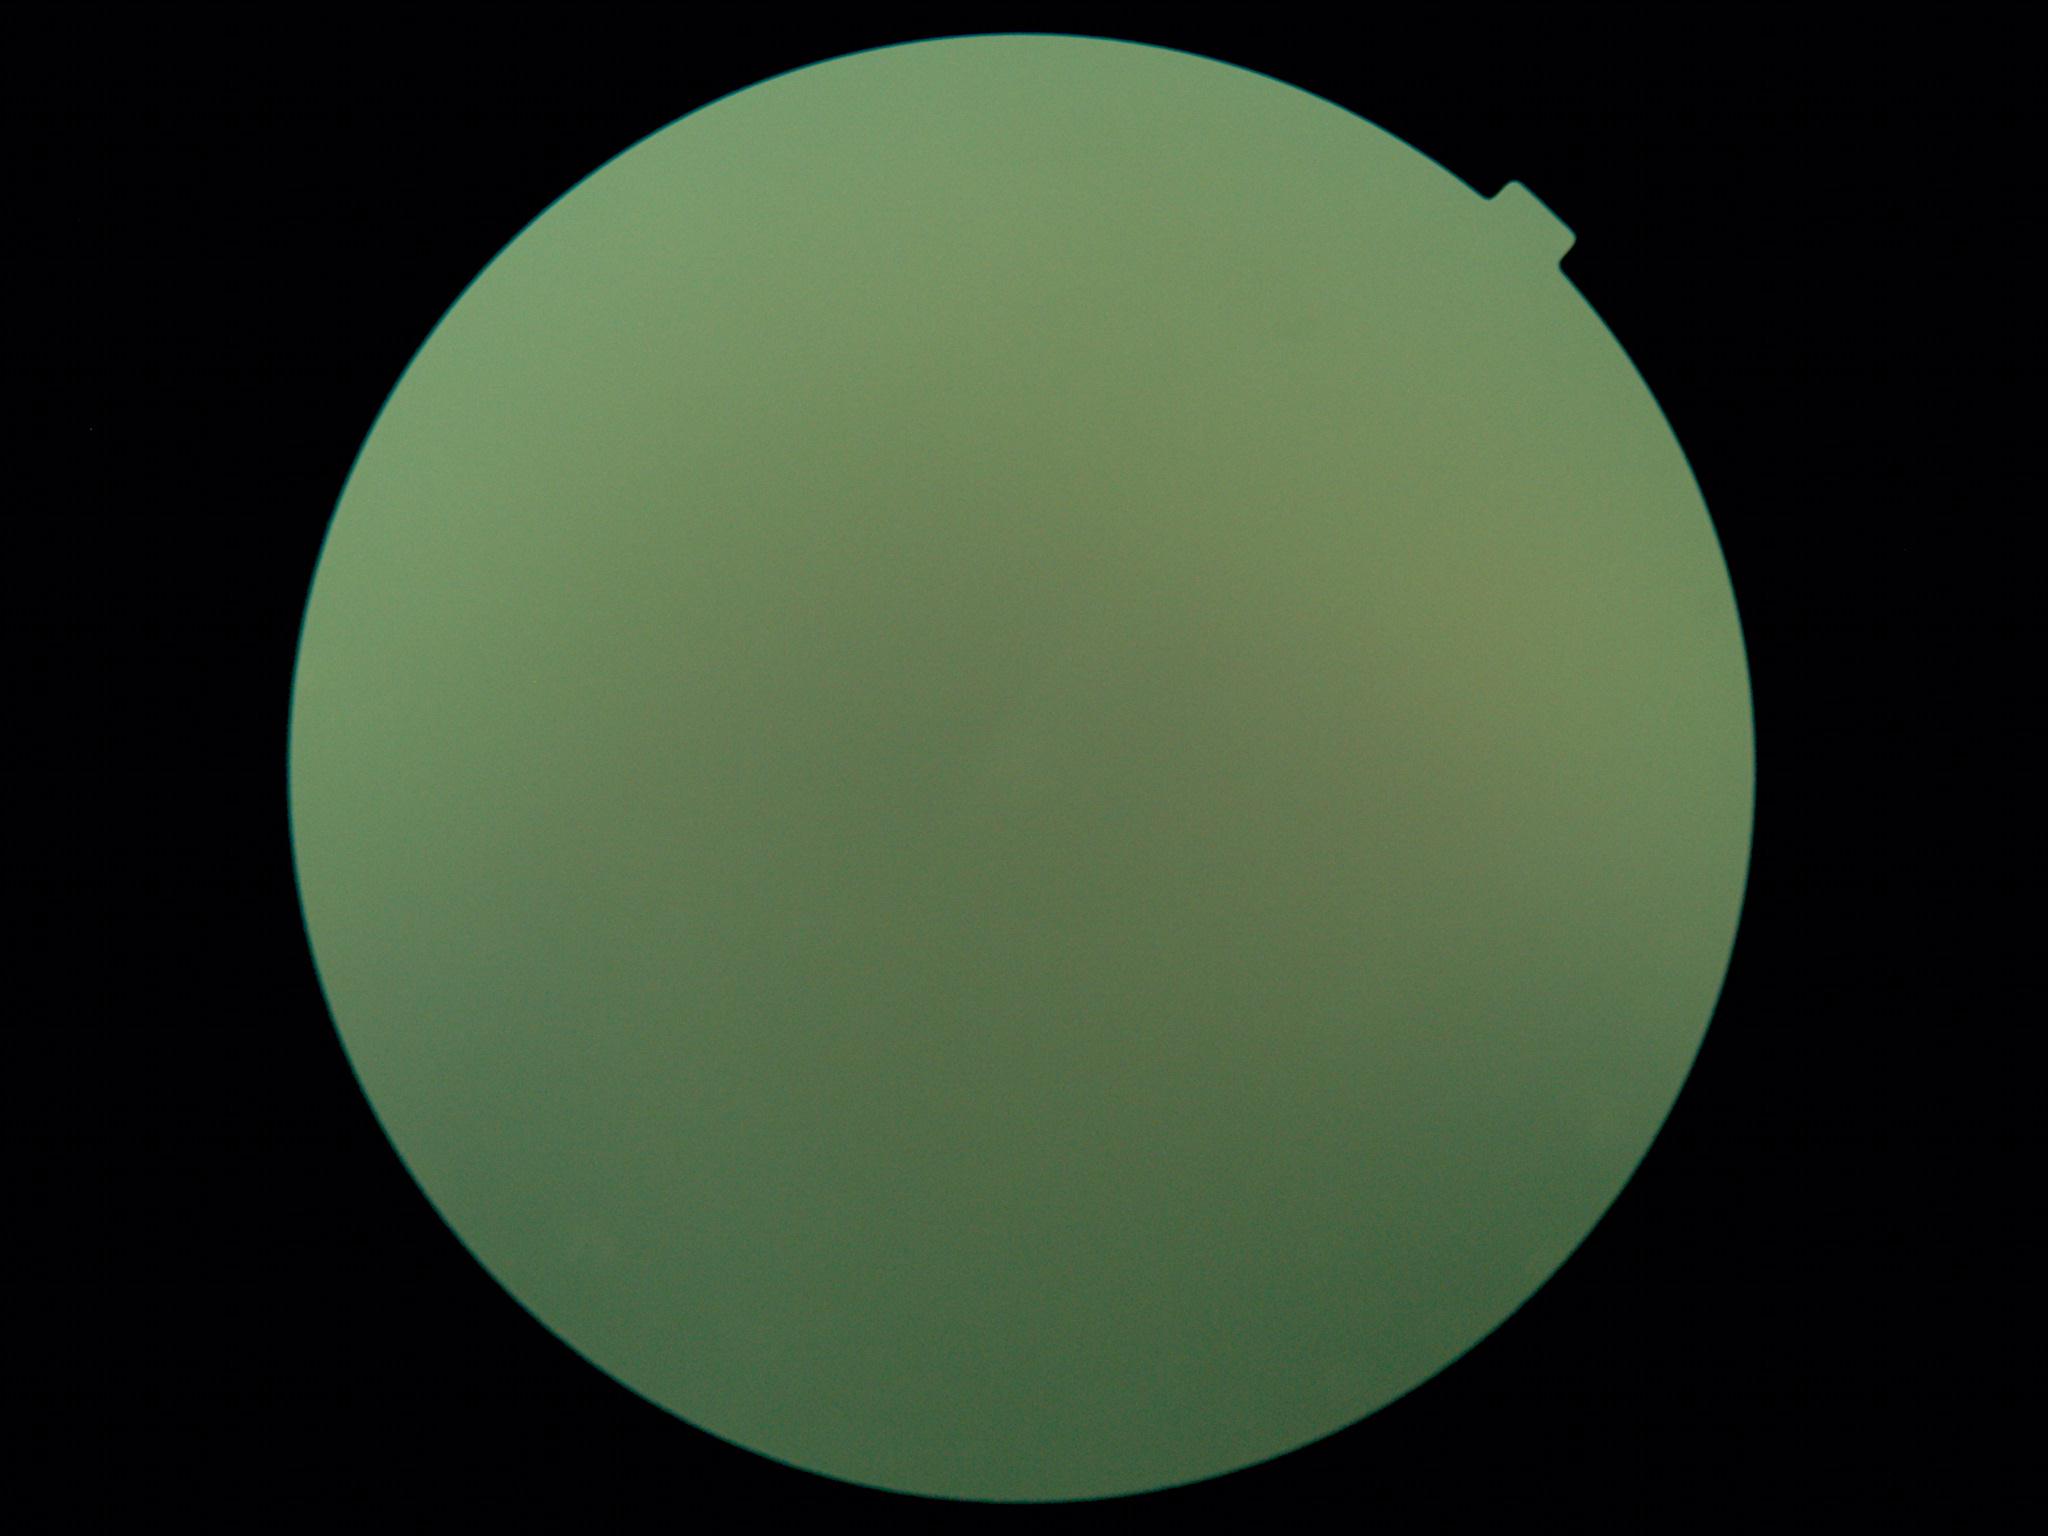
DR stage is ungradable due to poor image quality.